FOV: 45 degrees:
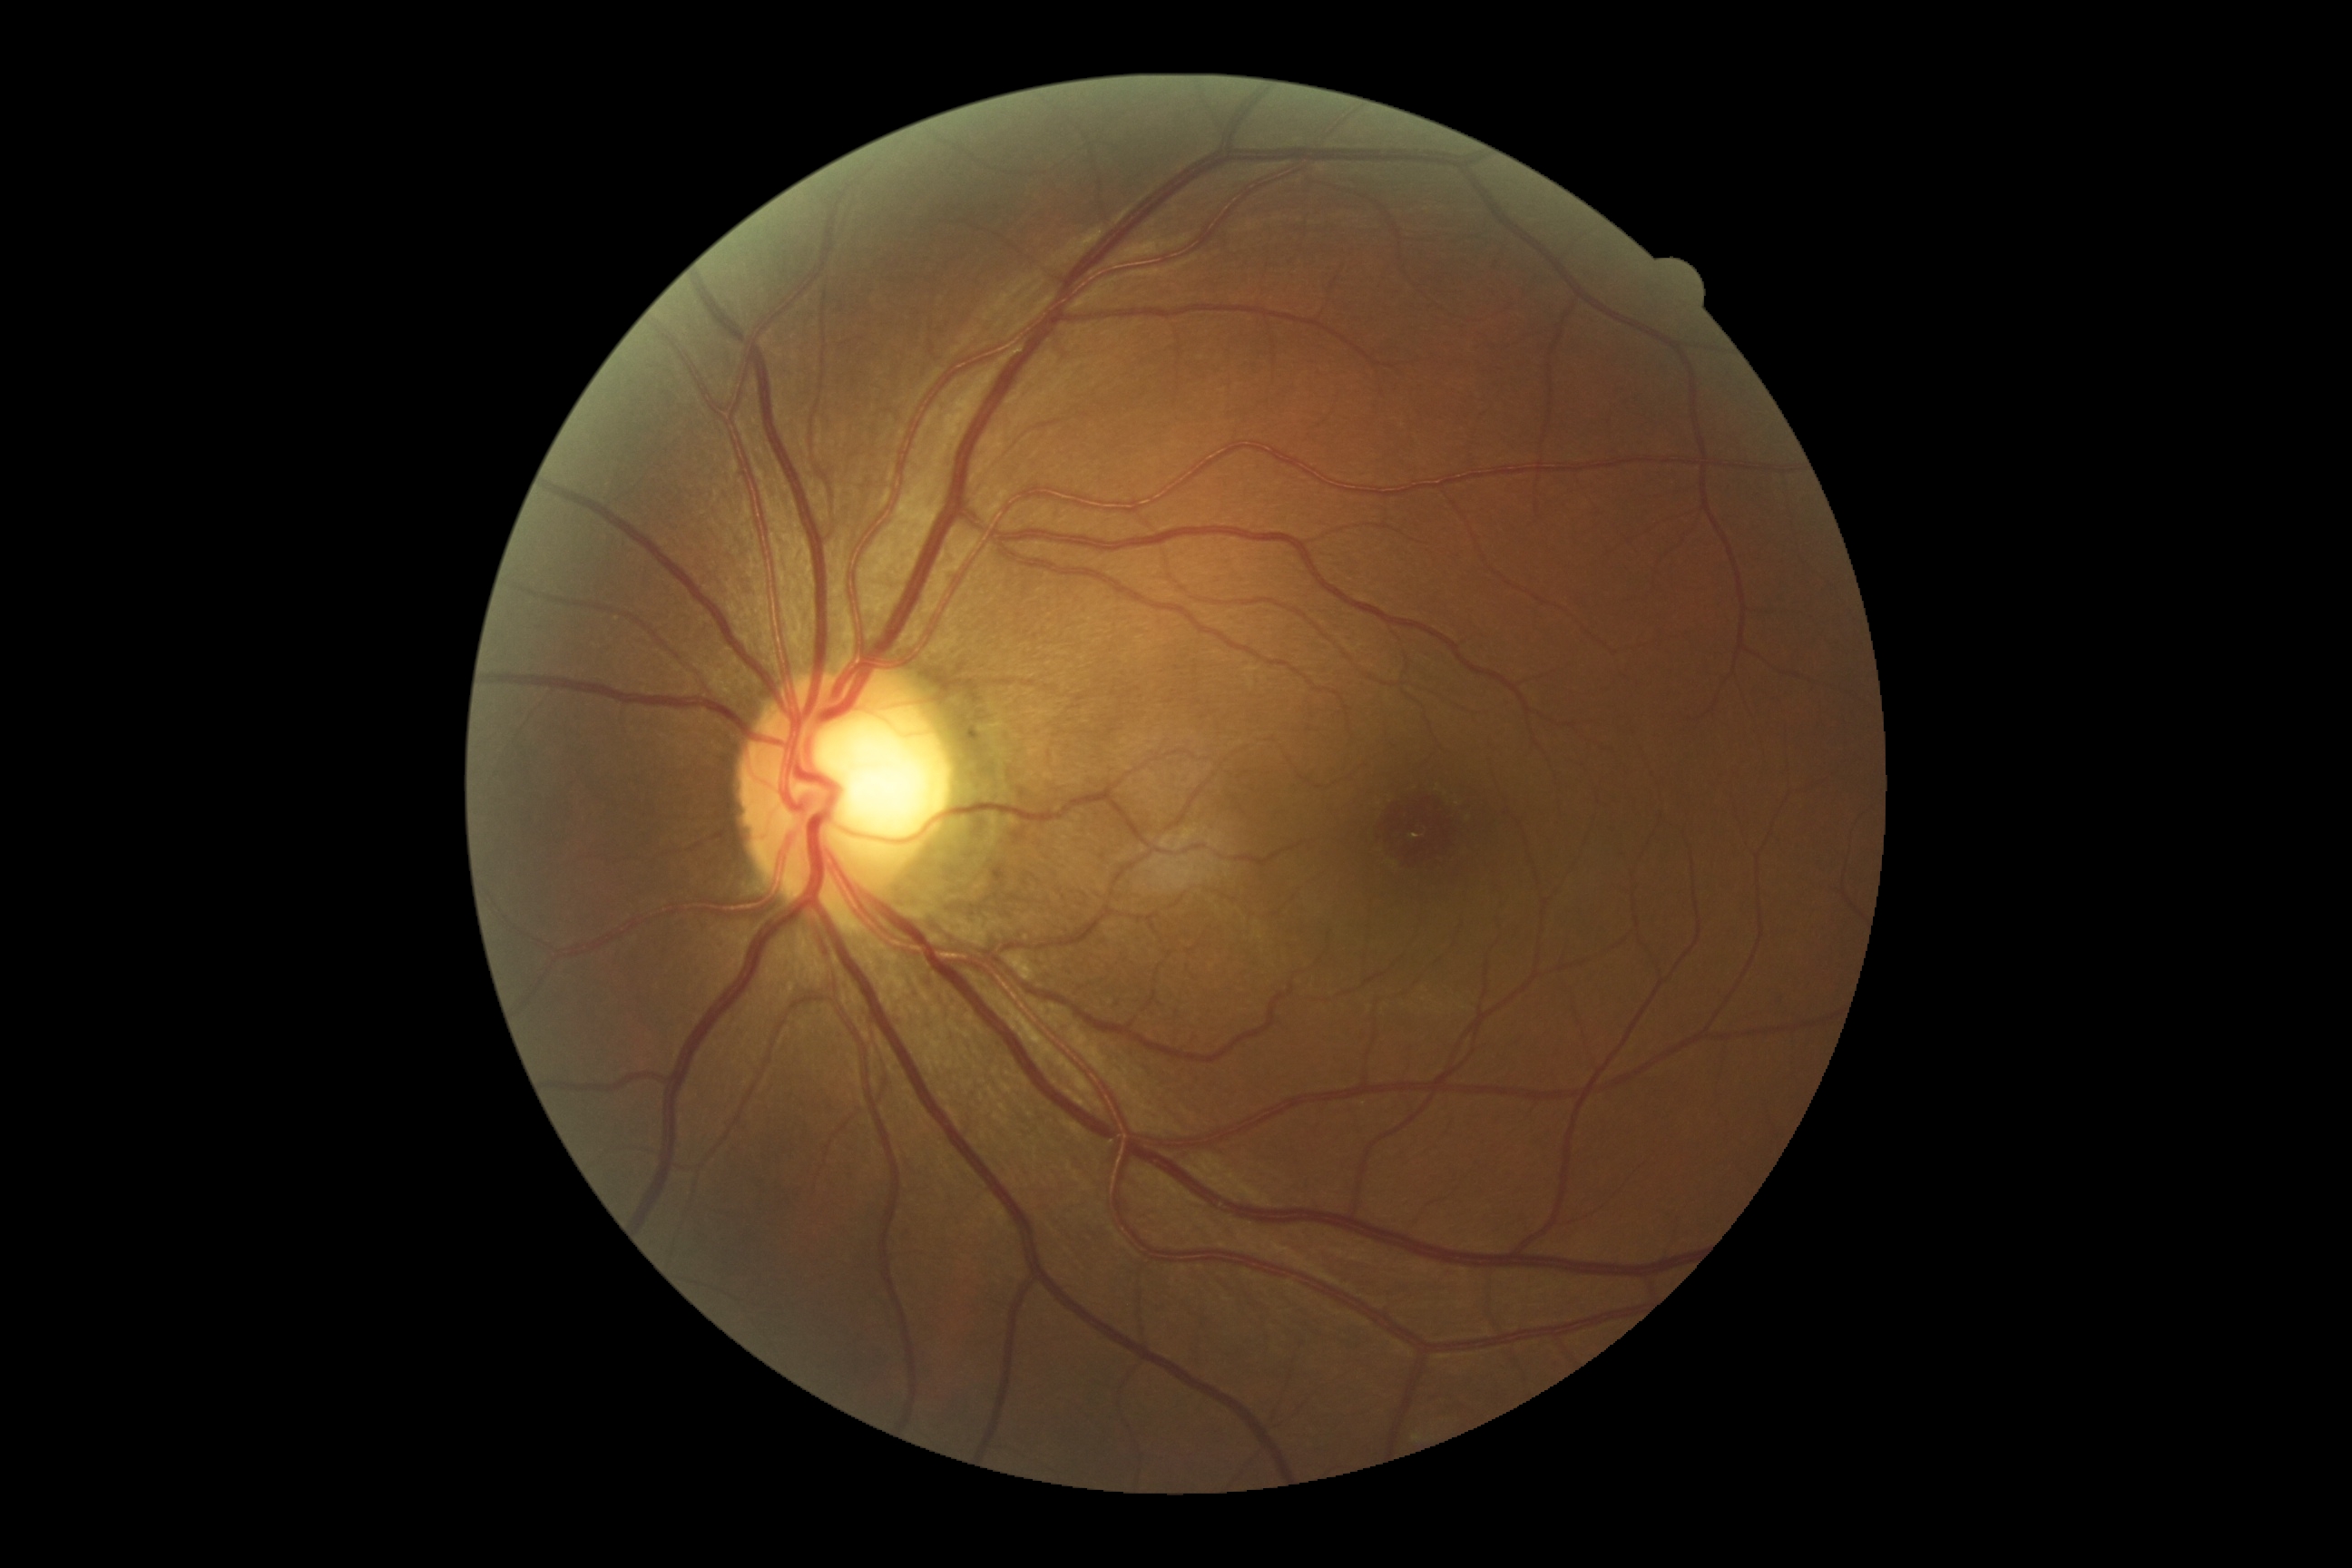

DR grade: 0 (no apparent retinopathy) | DR impression: no DR findings.